Pediatric retinal photograph (wide-field) · 1240 x 1240 pixels · camera: Phoenix ICON (100° FOV).
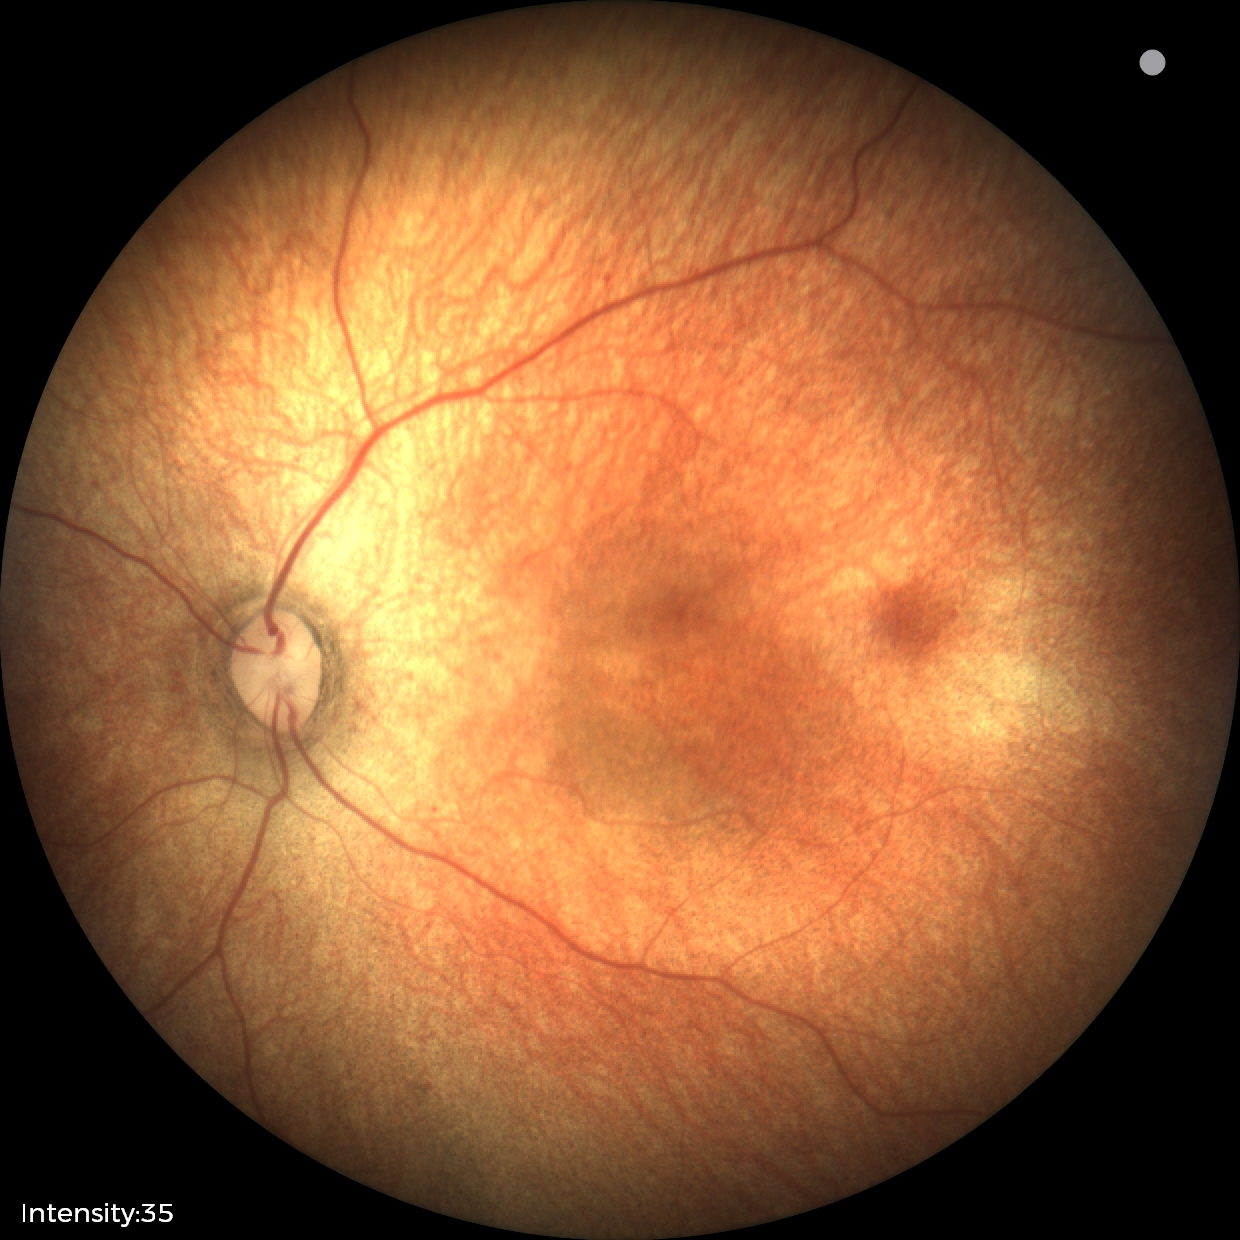
Screening examination with no abnormal retinal findings.